Fundus photo:
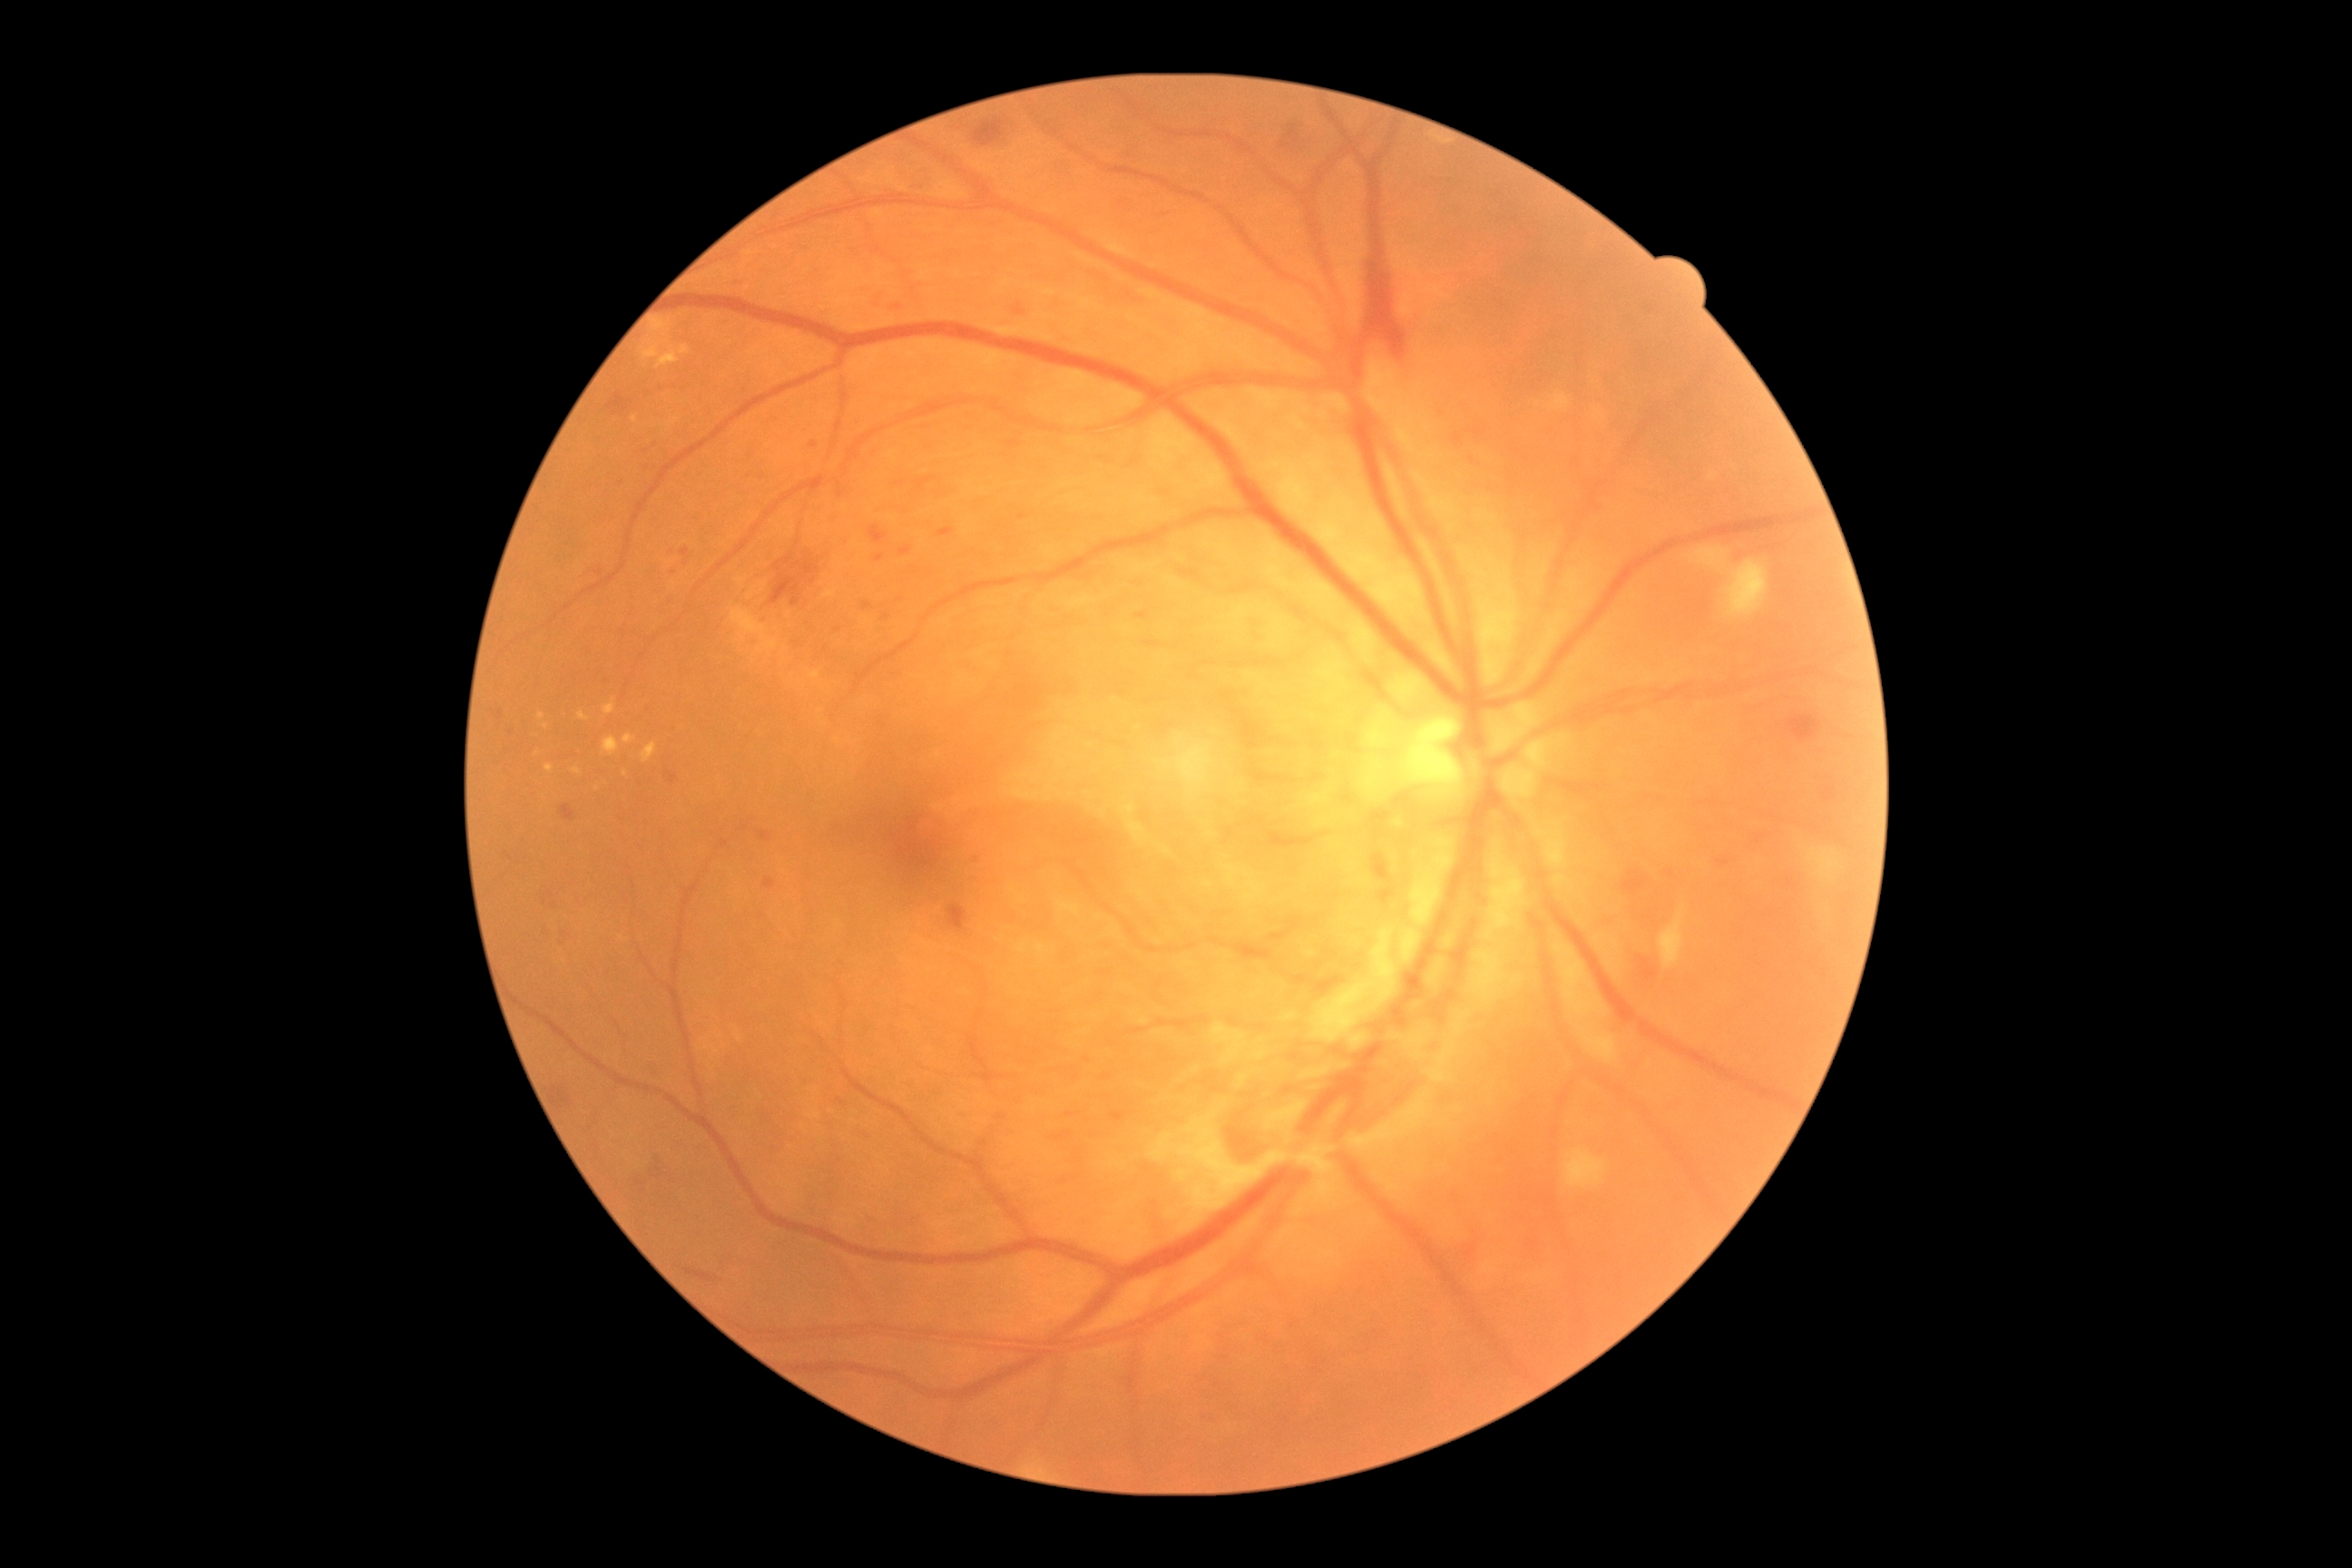

<lesions partial="true">
  <dr_grade>4</dr_grade>
  <he partial="true">l=1280, t=124, r=1302, b=150; l=1623, t=870, r=1649, b=897; l=1006, t=676, r=1046, b=714; l=1823, t=787, r=1836, b=801; l=763, t=879, r=776, b=890; l=974, t=119, r=1008, b=148; l=756, t=830, r=774, b=843; l=1638, t=956, r=1658, b=981; l=770, t=551, r=821, b=607; l=553, t=1088, r=571, b=1106; l=868, t=525, r=888, b=545; l=652, t=1155, r=663, b=1179</he>
  <ma partial="true">l=876, t=554, r=885, b=562; l=1008, t=440, r=1021, b=449; l=1467, t=429, r=1485, b=440; l=810, t=442, r=818, b=449; l=1102, t=1075, r=1112, b=1081; l=680, t=549, r=691, b=556; l=863, t=603, r=874, b=611; l=1453, t=433, r=1464, b=447; l=493, t=710, r=504, b=721; l=1716, t=858, r=1730, b=867</ma>
  <ma_small_centers>(551,894); (647,451); (914,570); (837,629); (620,484)</ma_small_centers>
</lesions>